CFP, 1725x1721px — 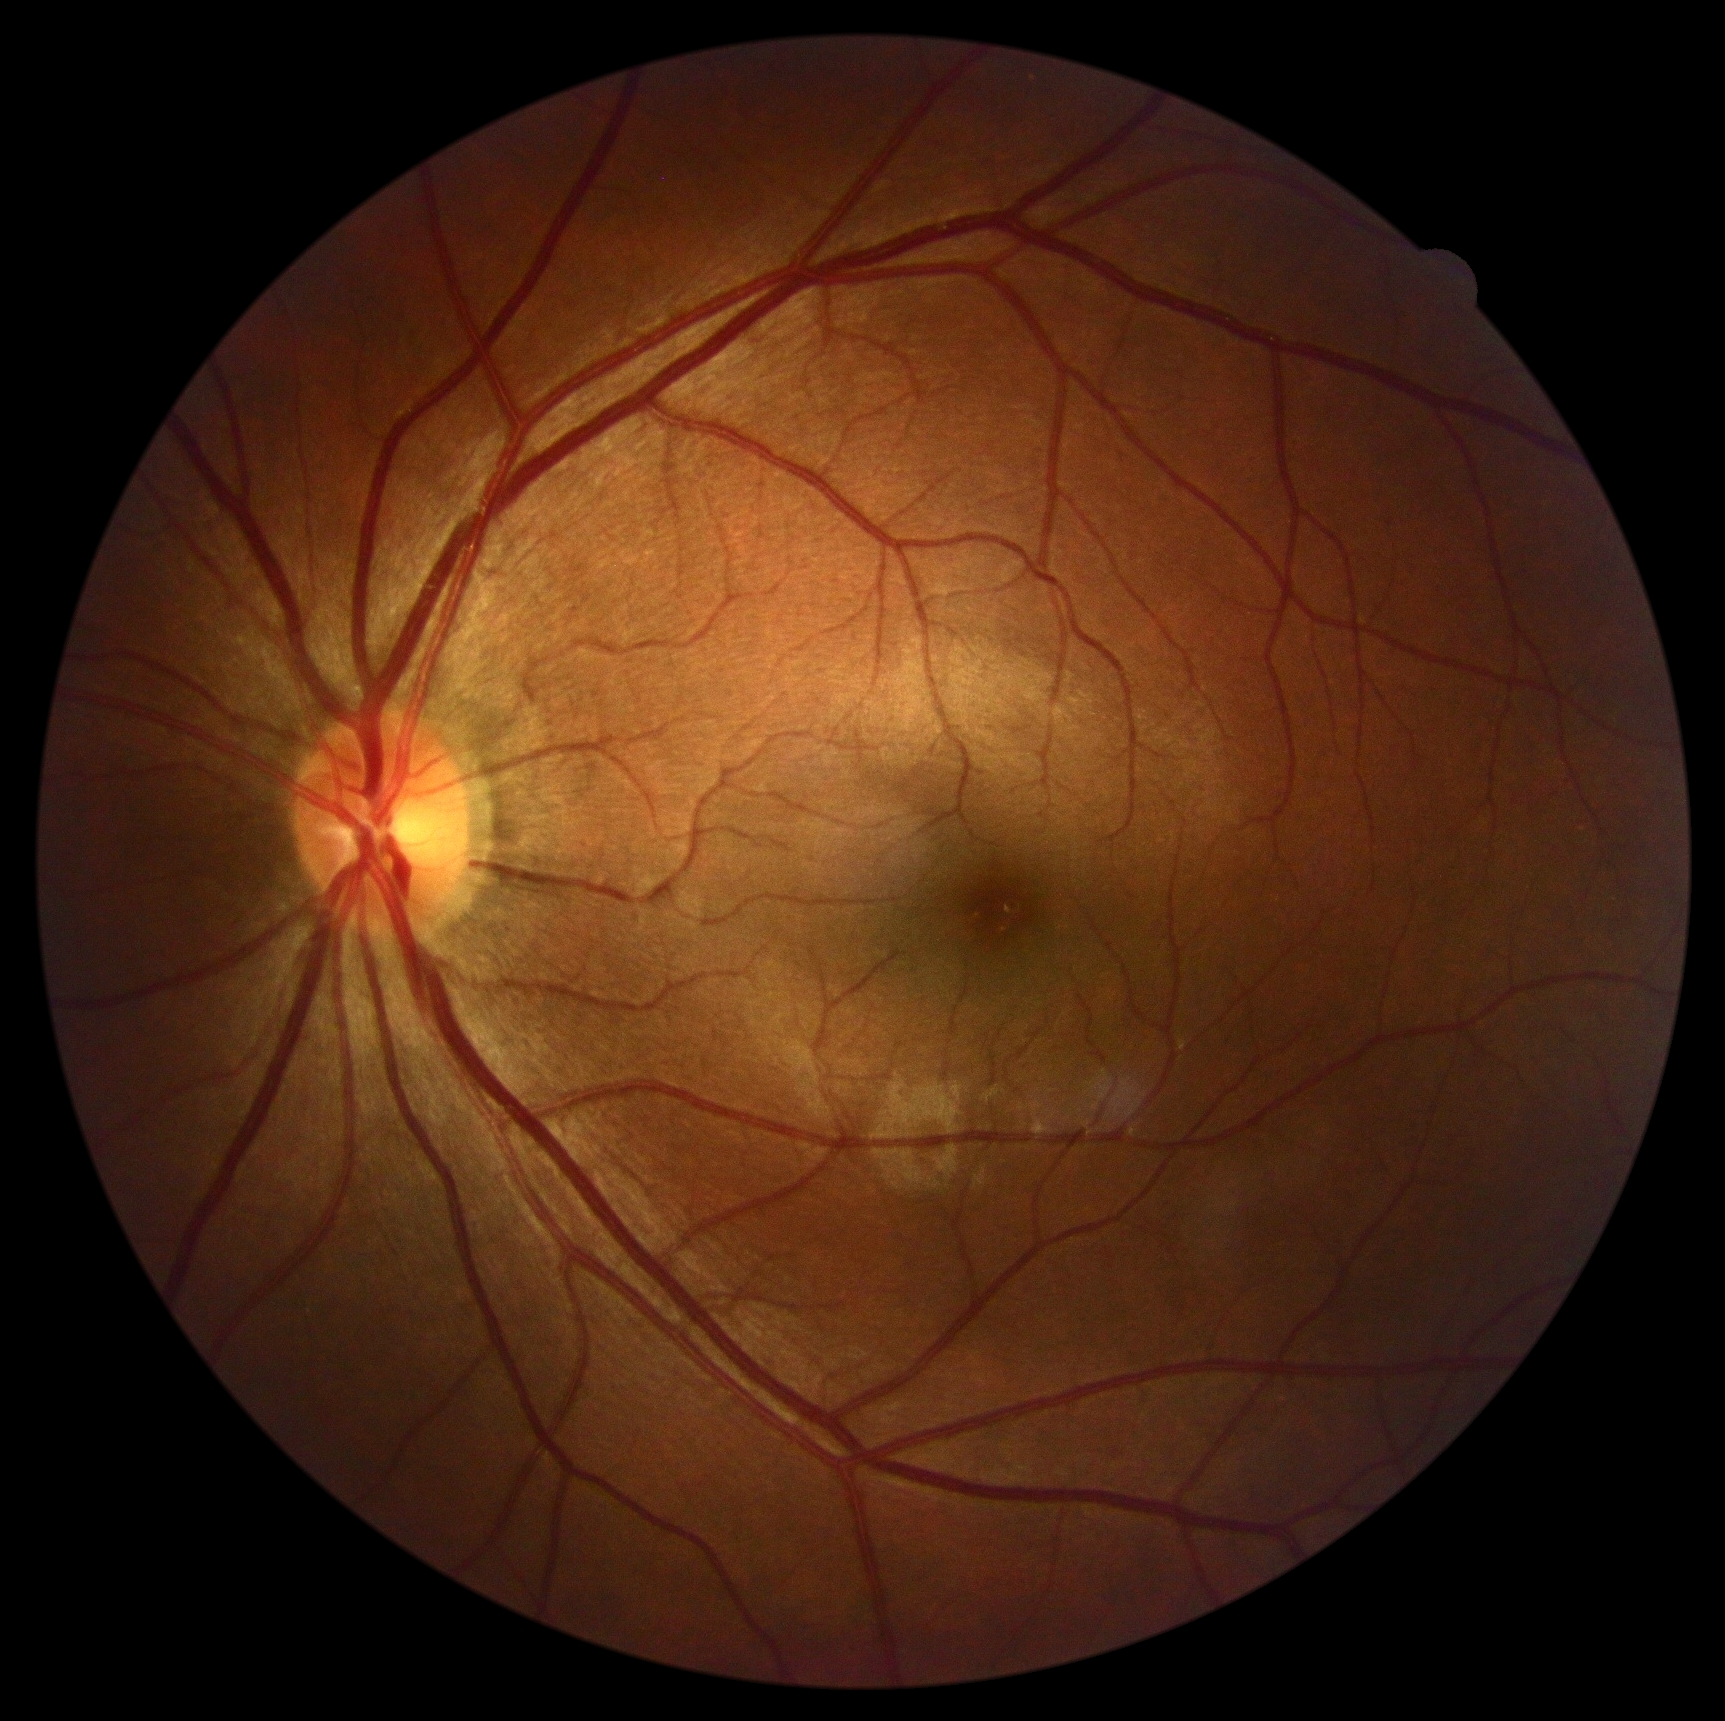

{
  "dr_grade": "no apparent diabetic retinopathy (grade 0) — no visible signs of diabetic retinopathy"
}